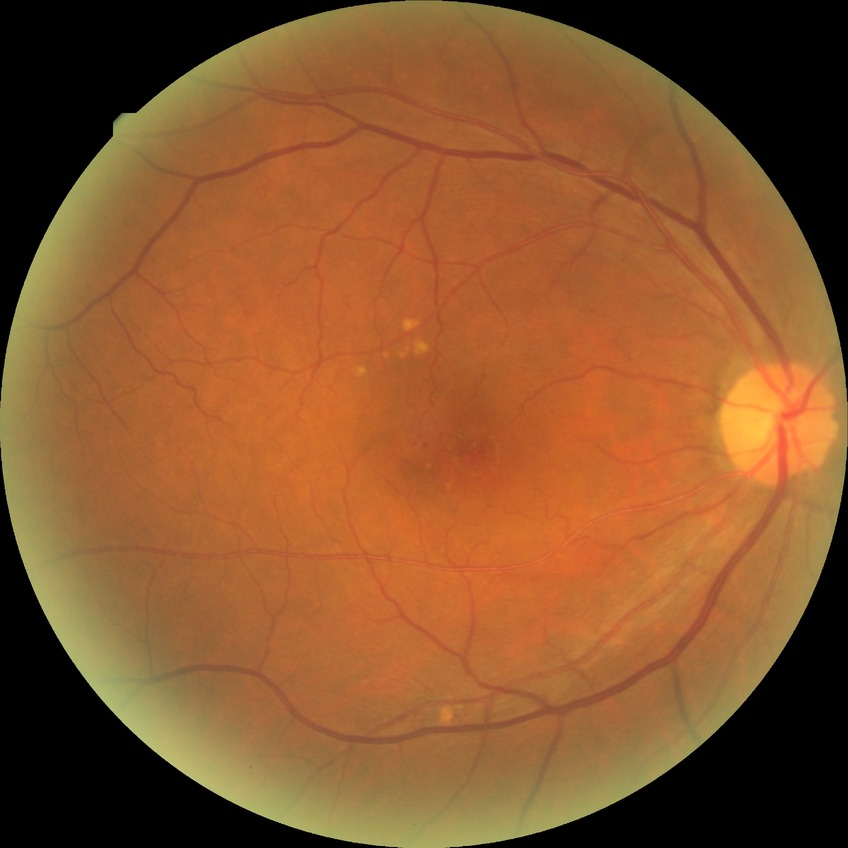 - DR severity — SDR